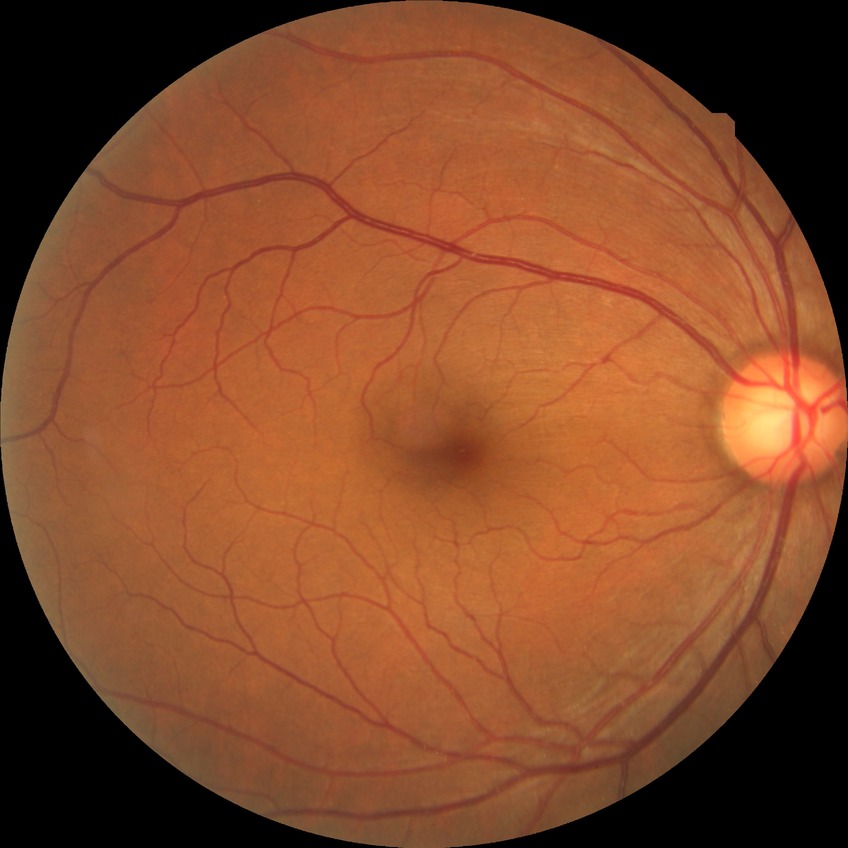
Diabetic retinopathy grade is no diabetic retinopathy.